45° field of view — 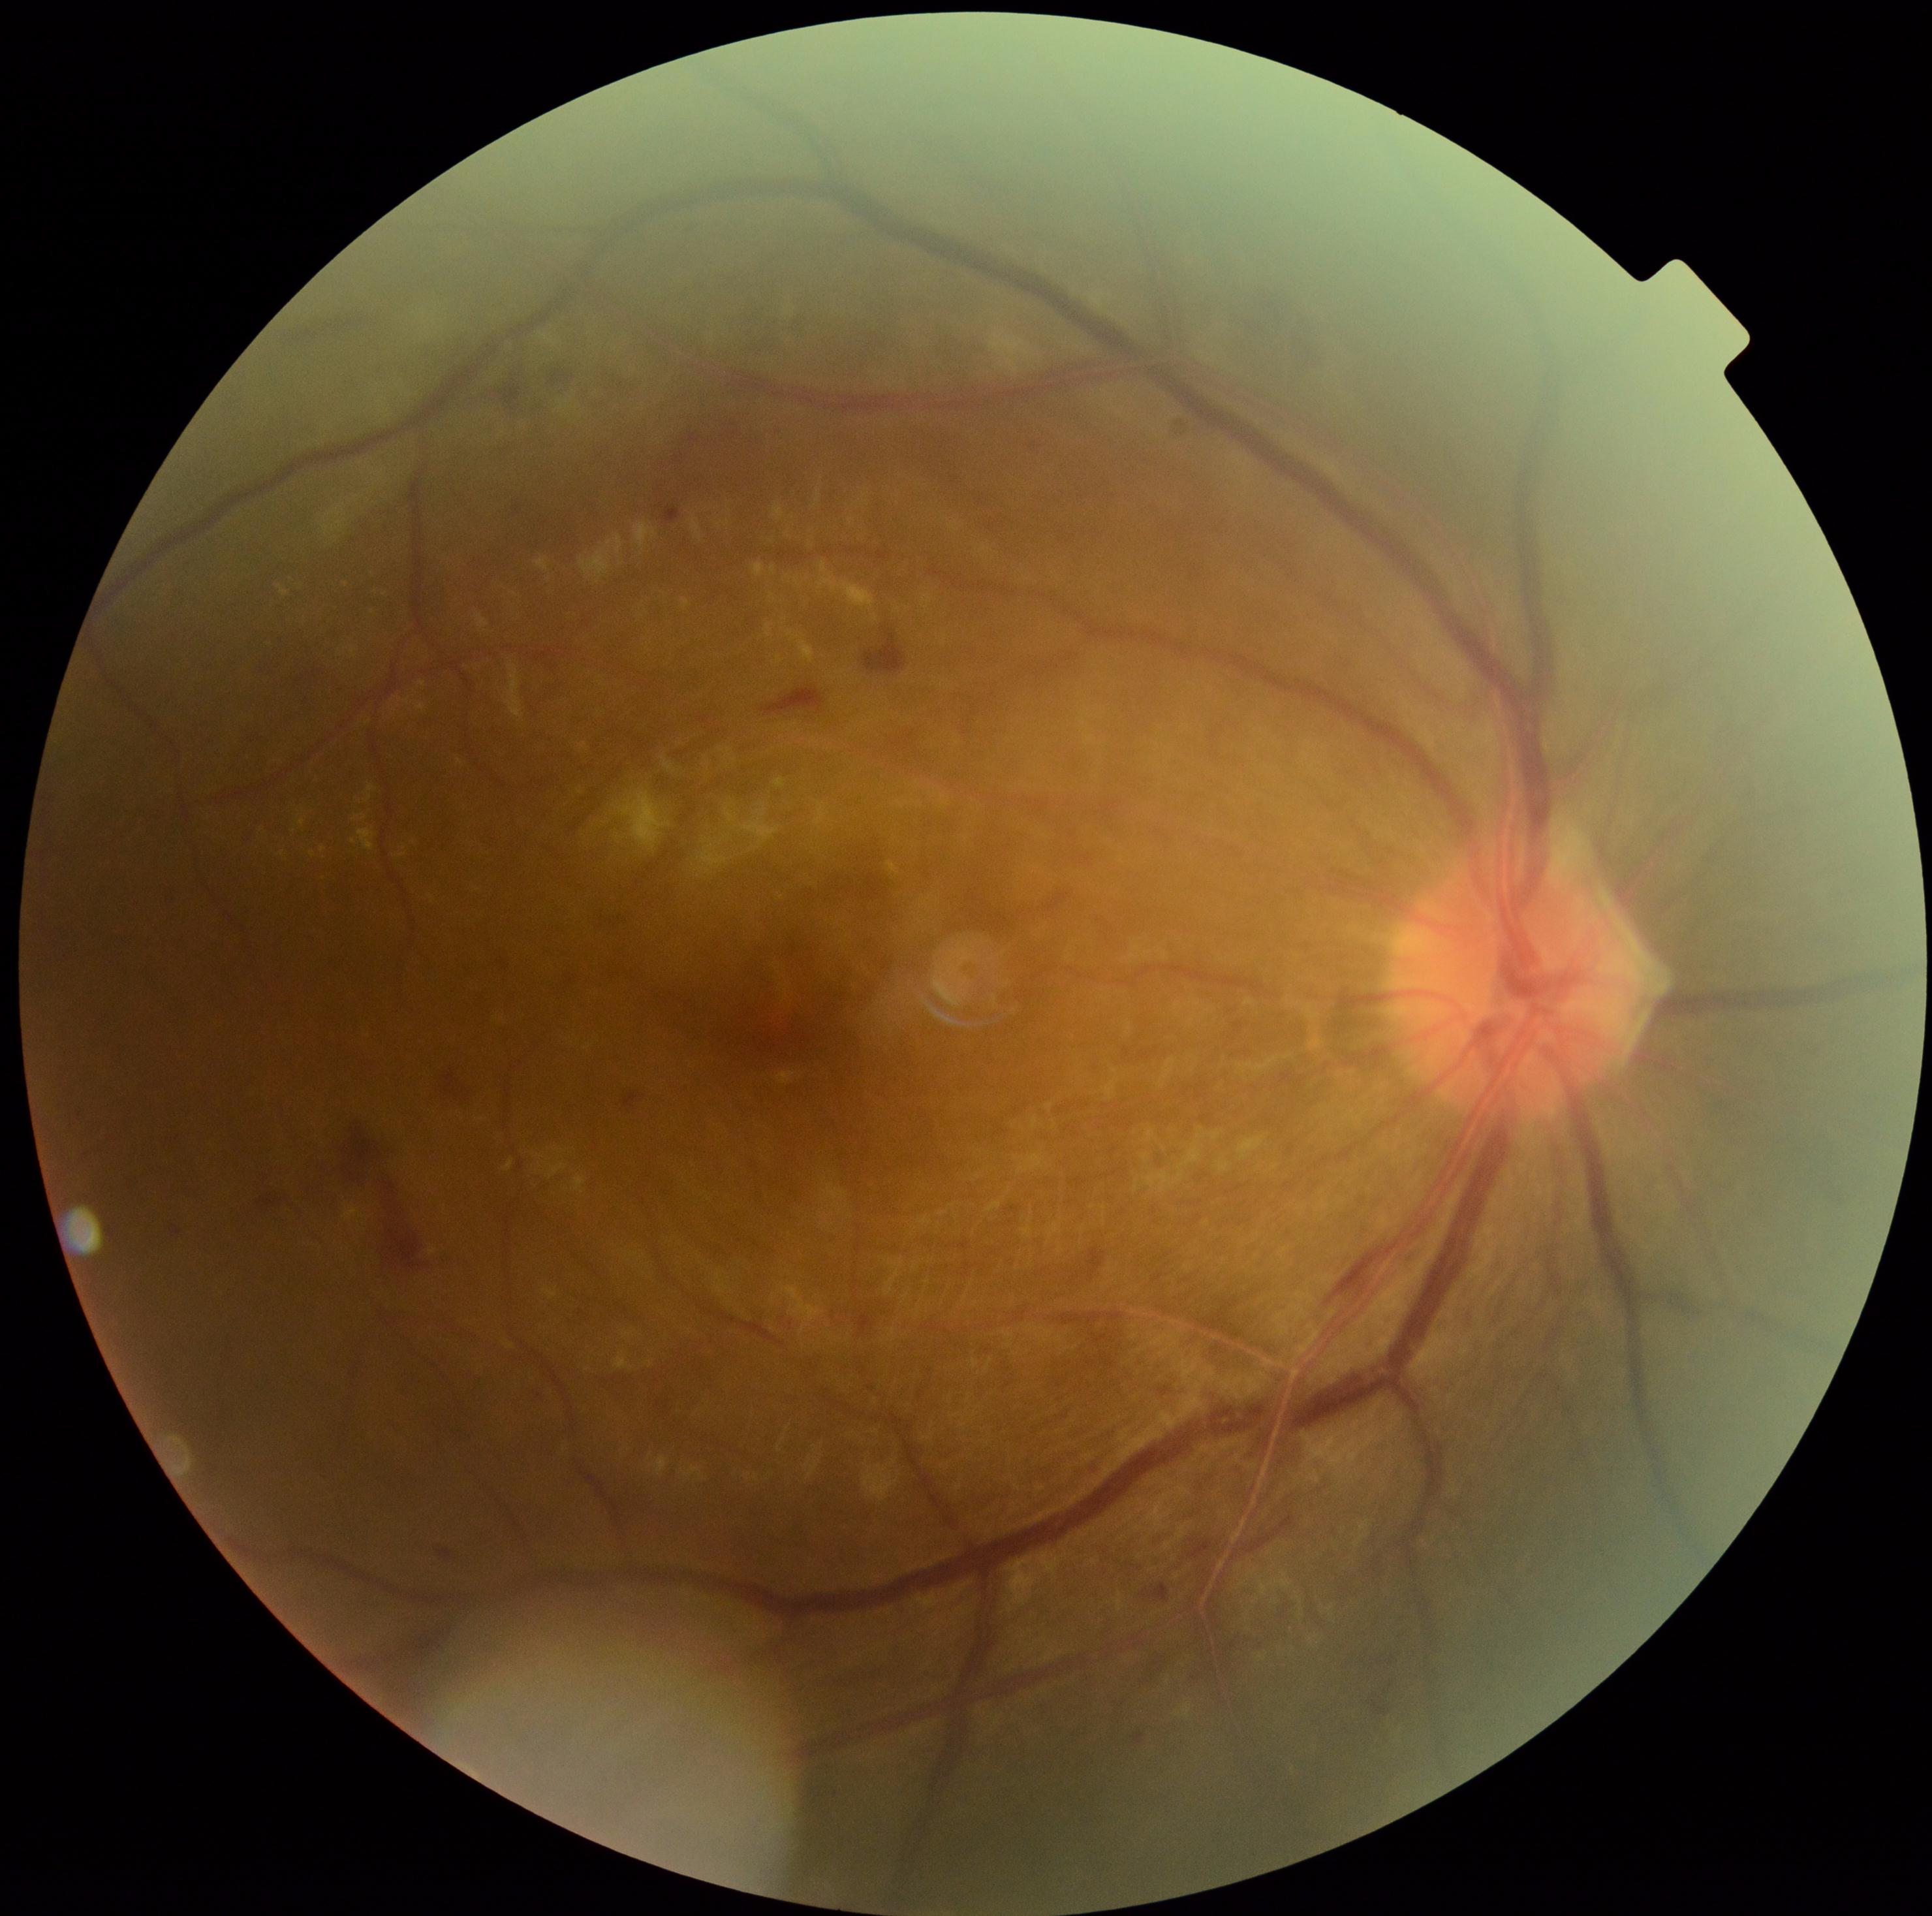
Annotations:
• diabetic retinopathy severity — 2/4